Color fundus image. 45° FOV. 2352 x 1568 pixels.
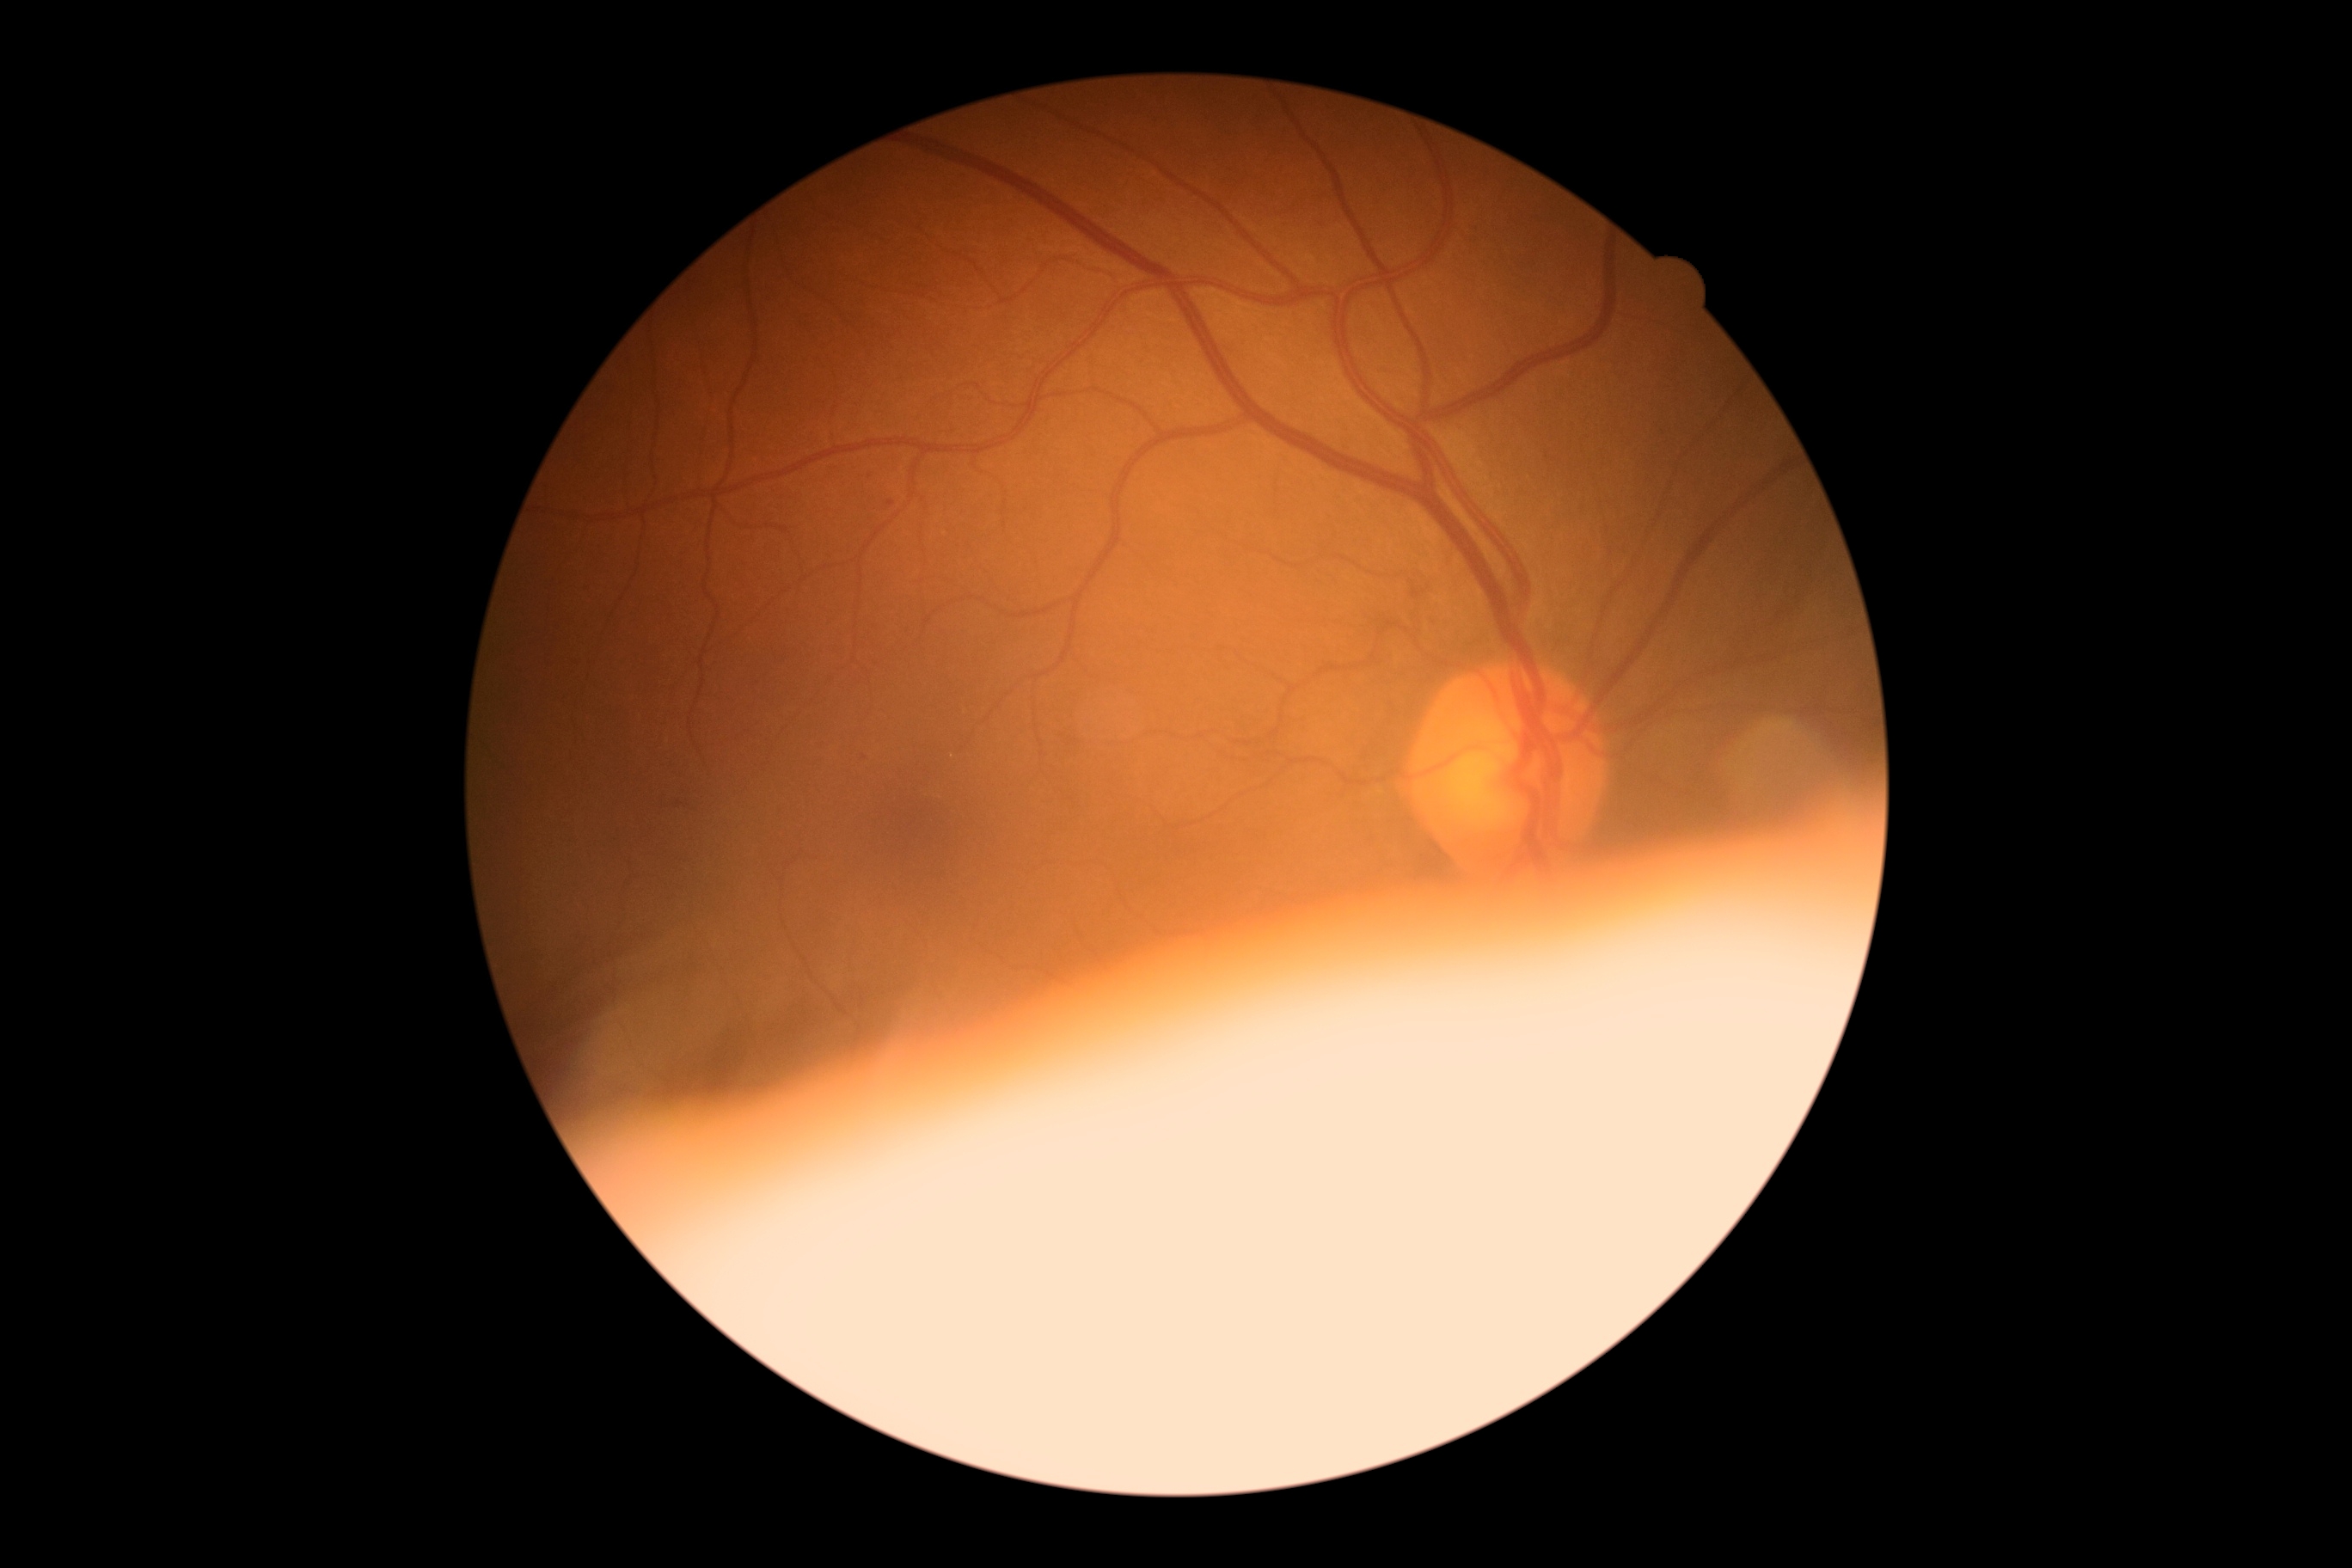 DR grade is mild non-proliferative diabetic retinopathy (1).